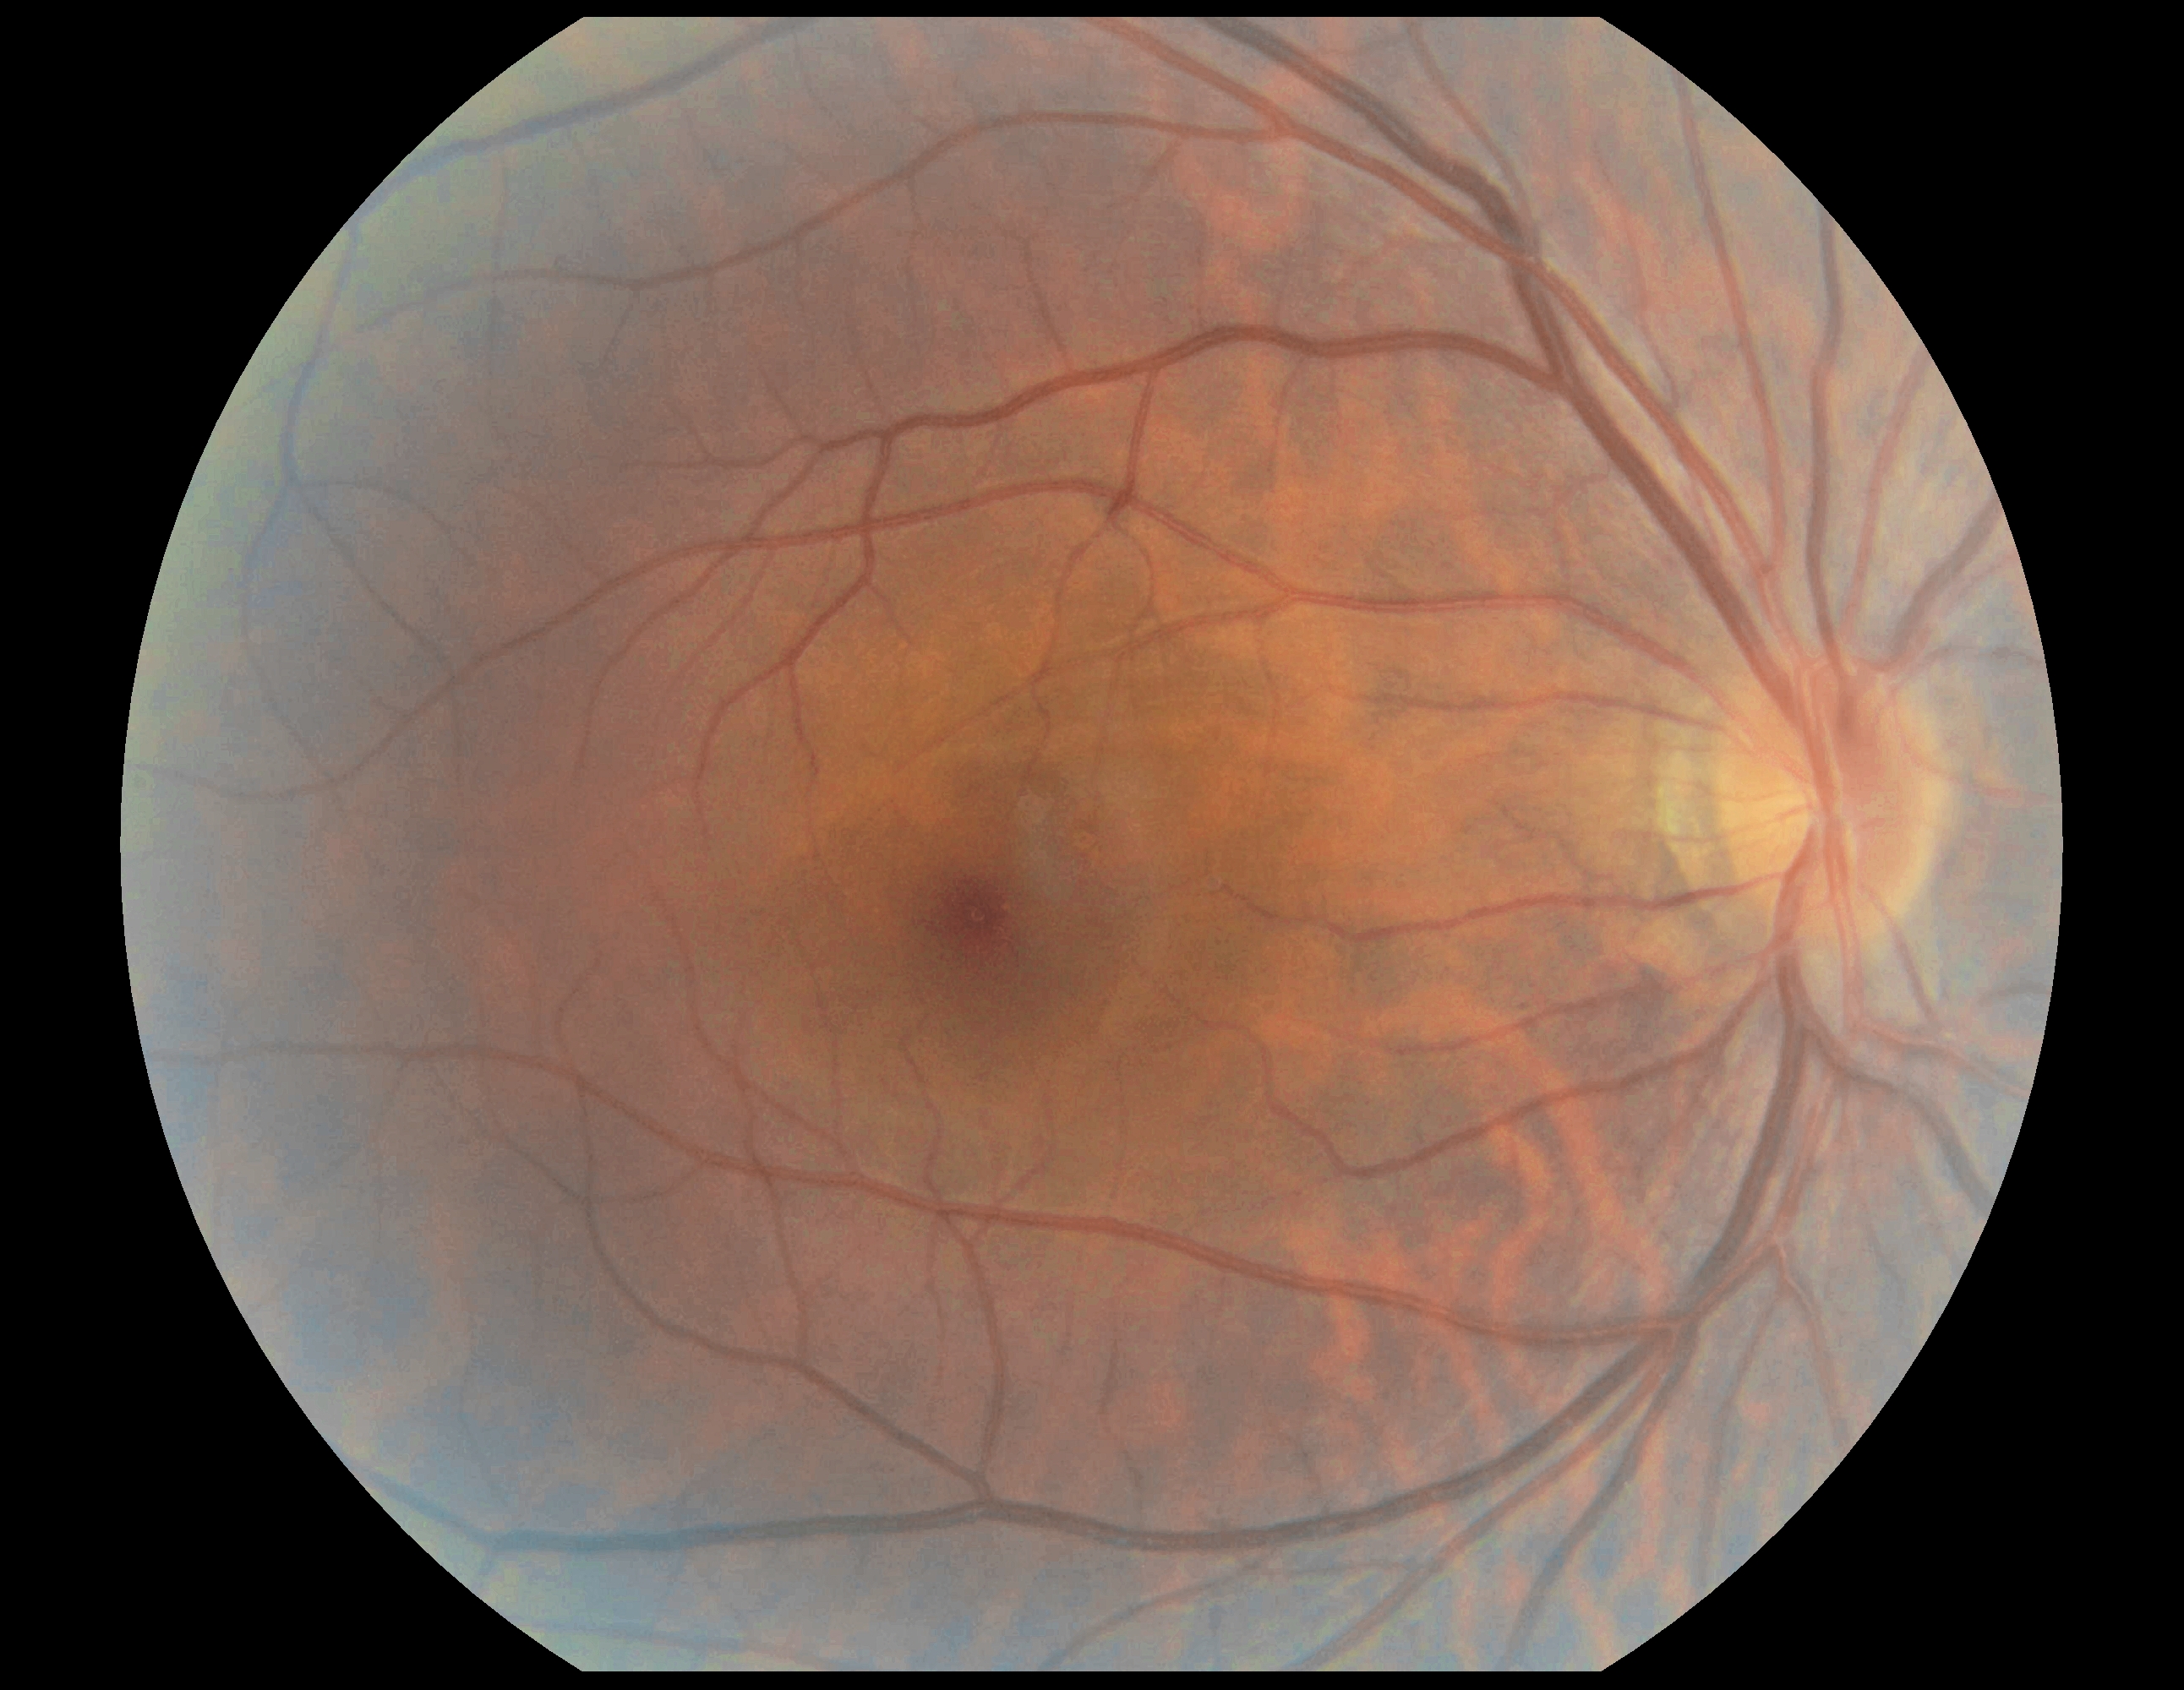
{"dr_grade": "grade 0 (no apparent retinopathy)"}